848 x 848 pixels — 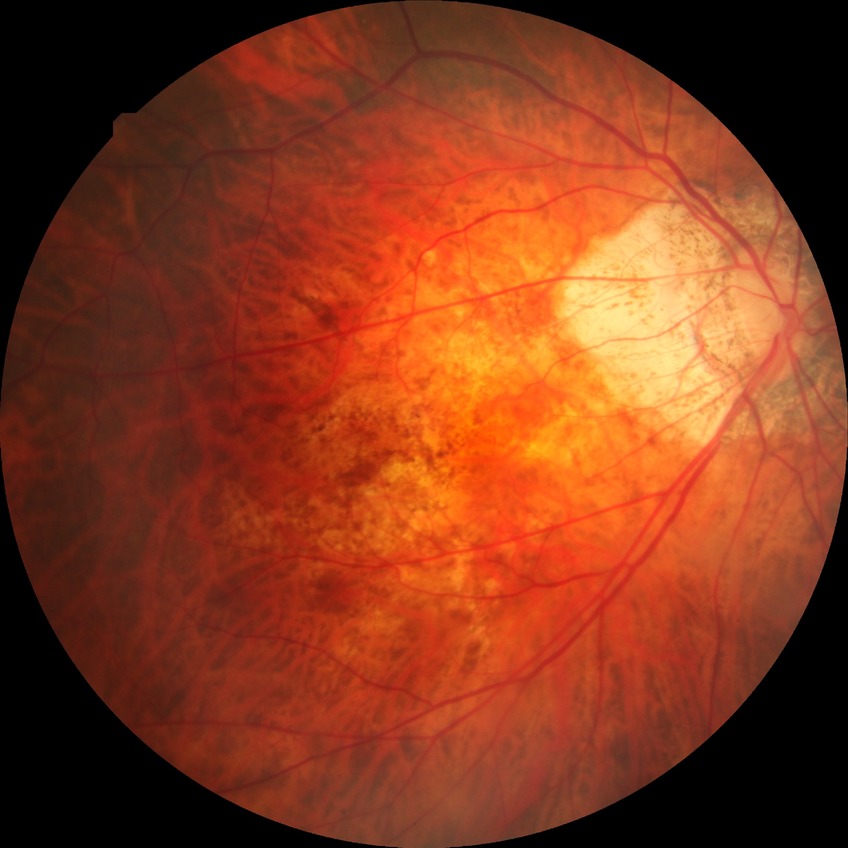 Retinopathy stage: no diabetic retinopathy.